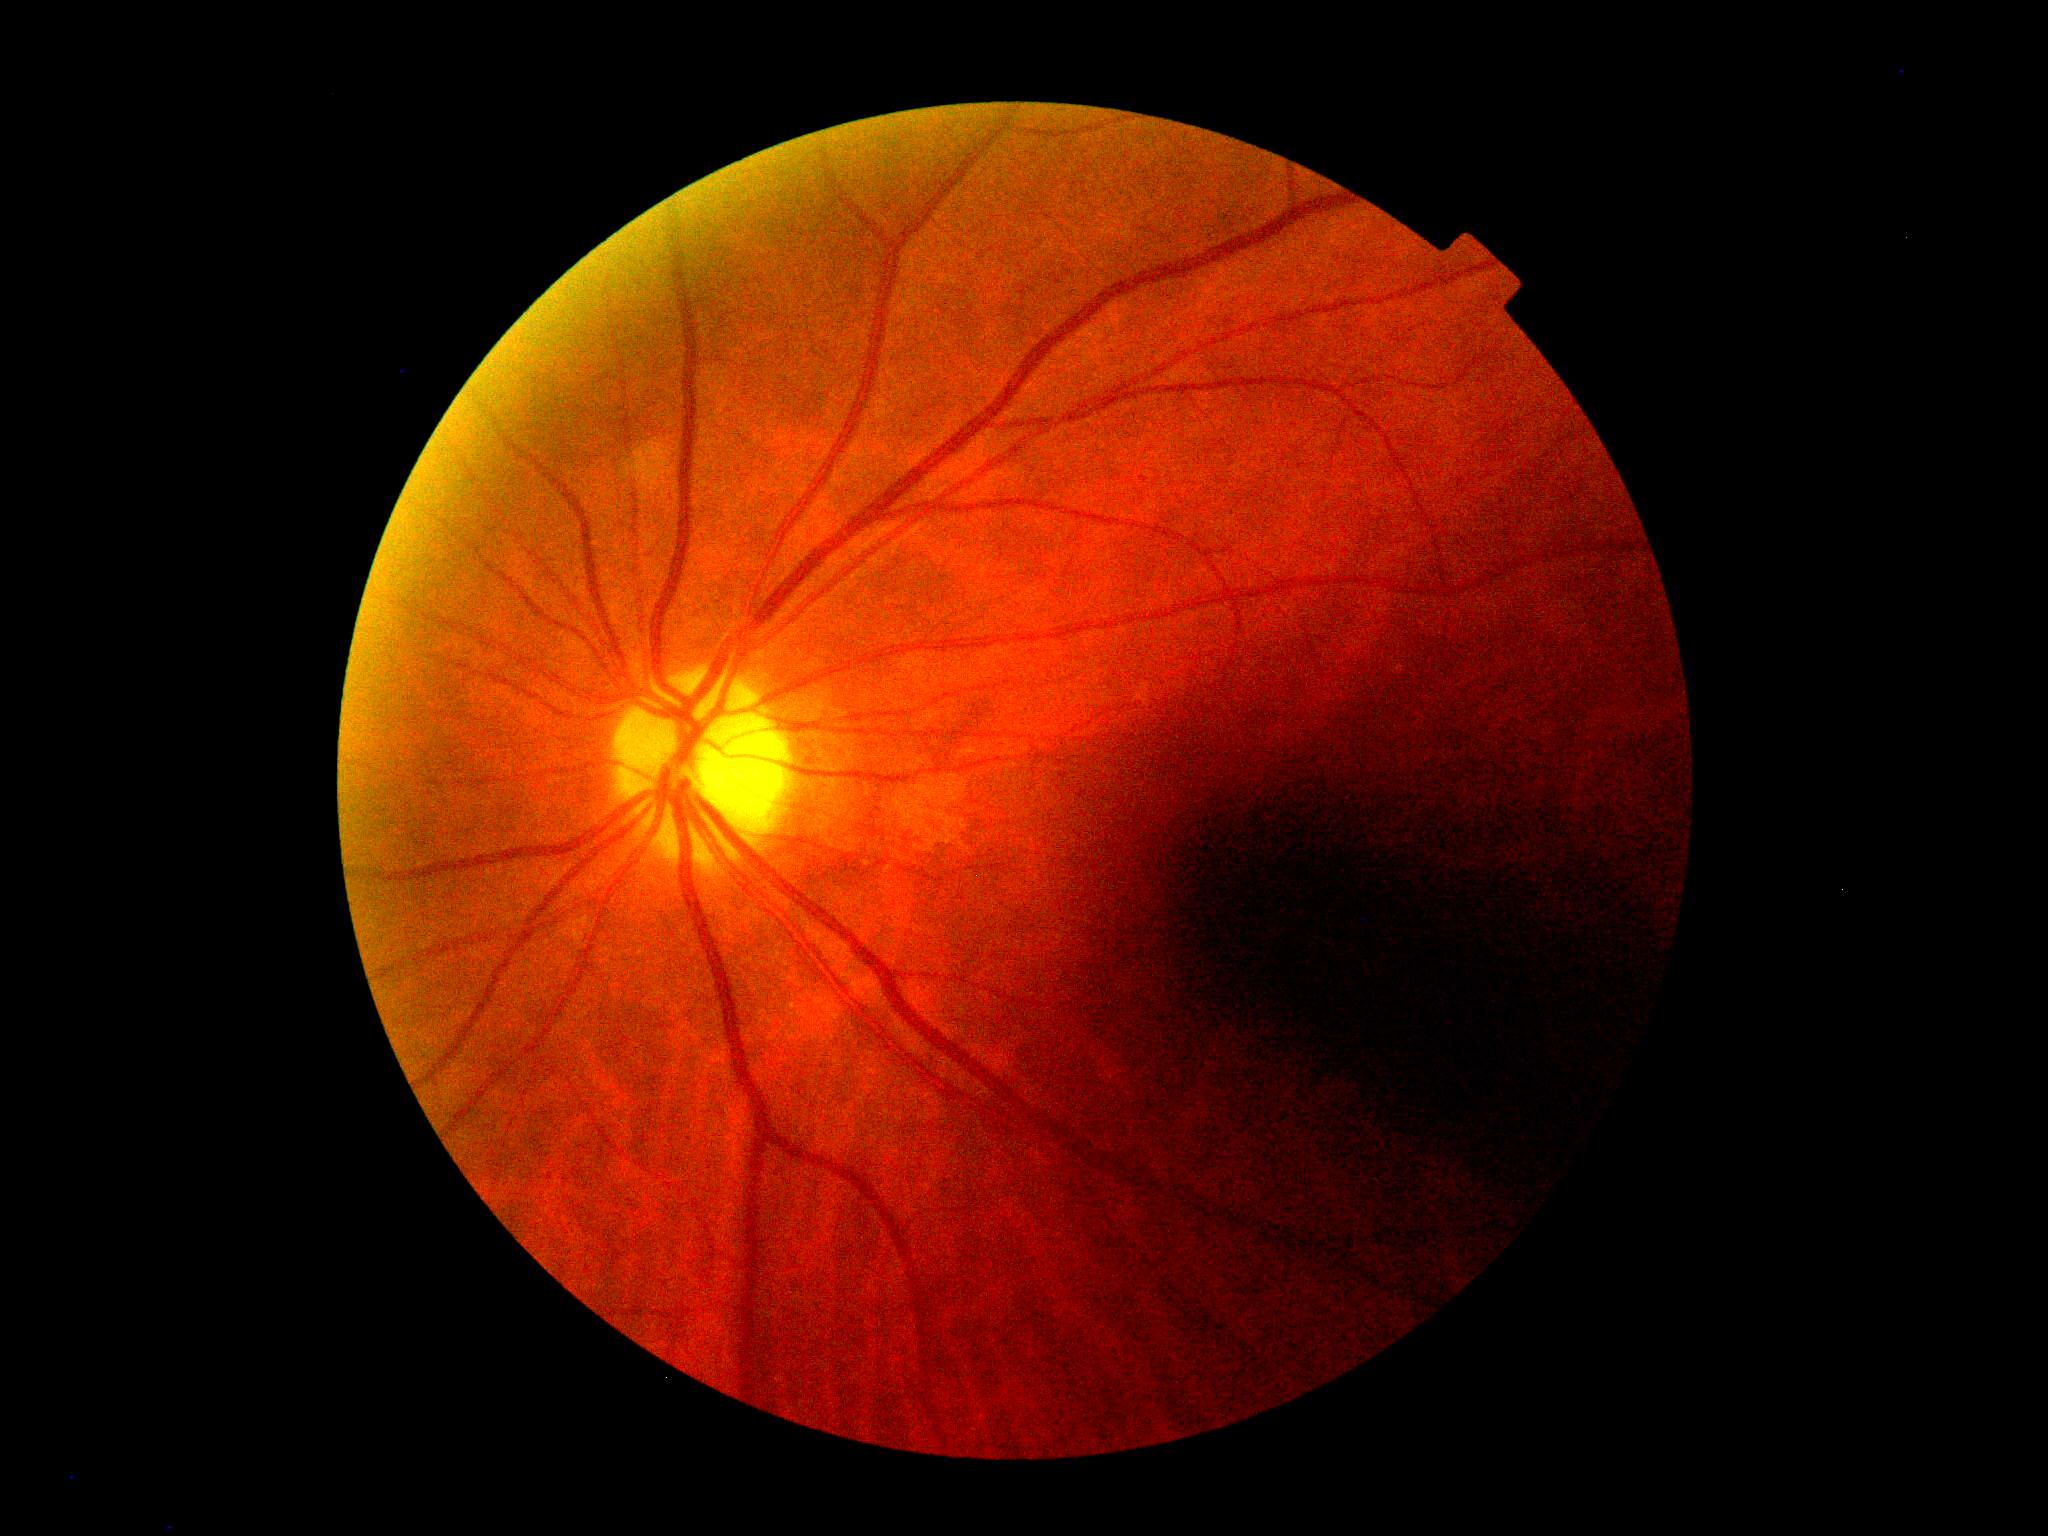

DR stage is 0/4.